Pediatric retinal photograph (wide-field): 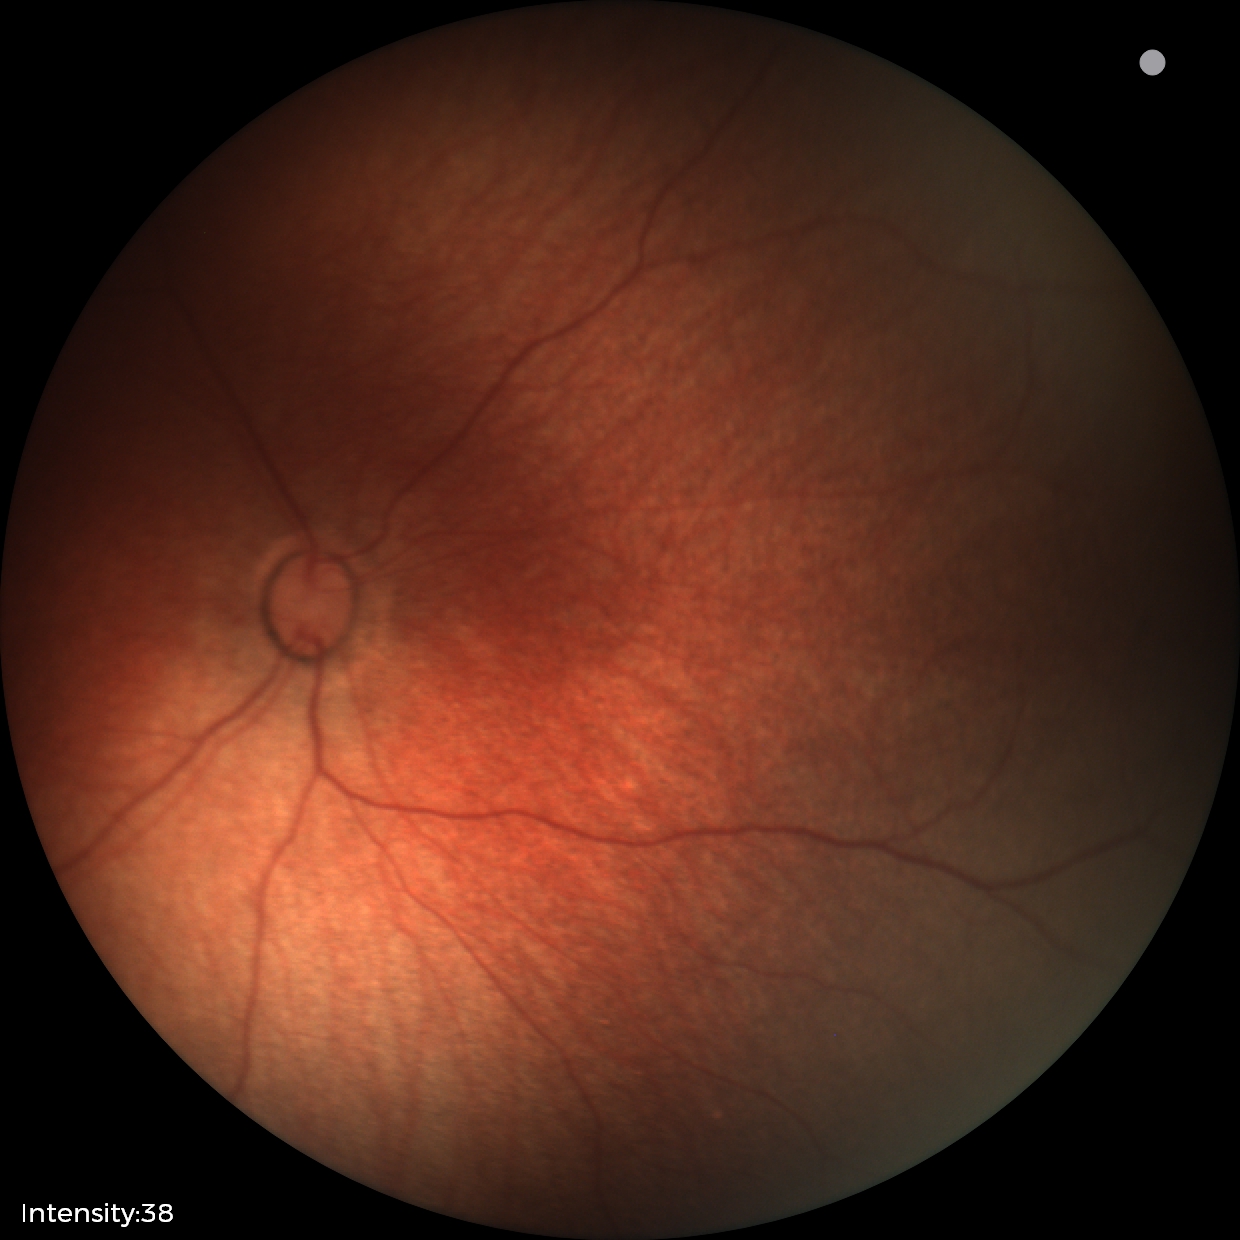 Physiological retinal appearance for postconceptual age.